45° FOV — 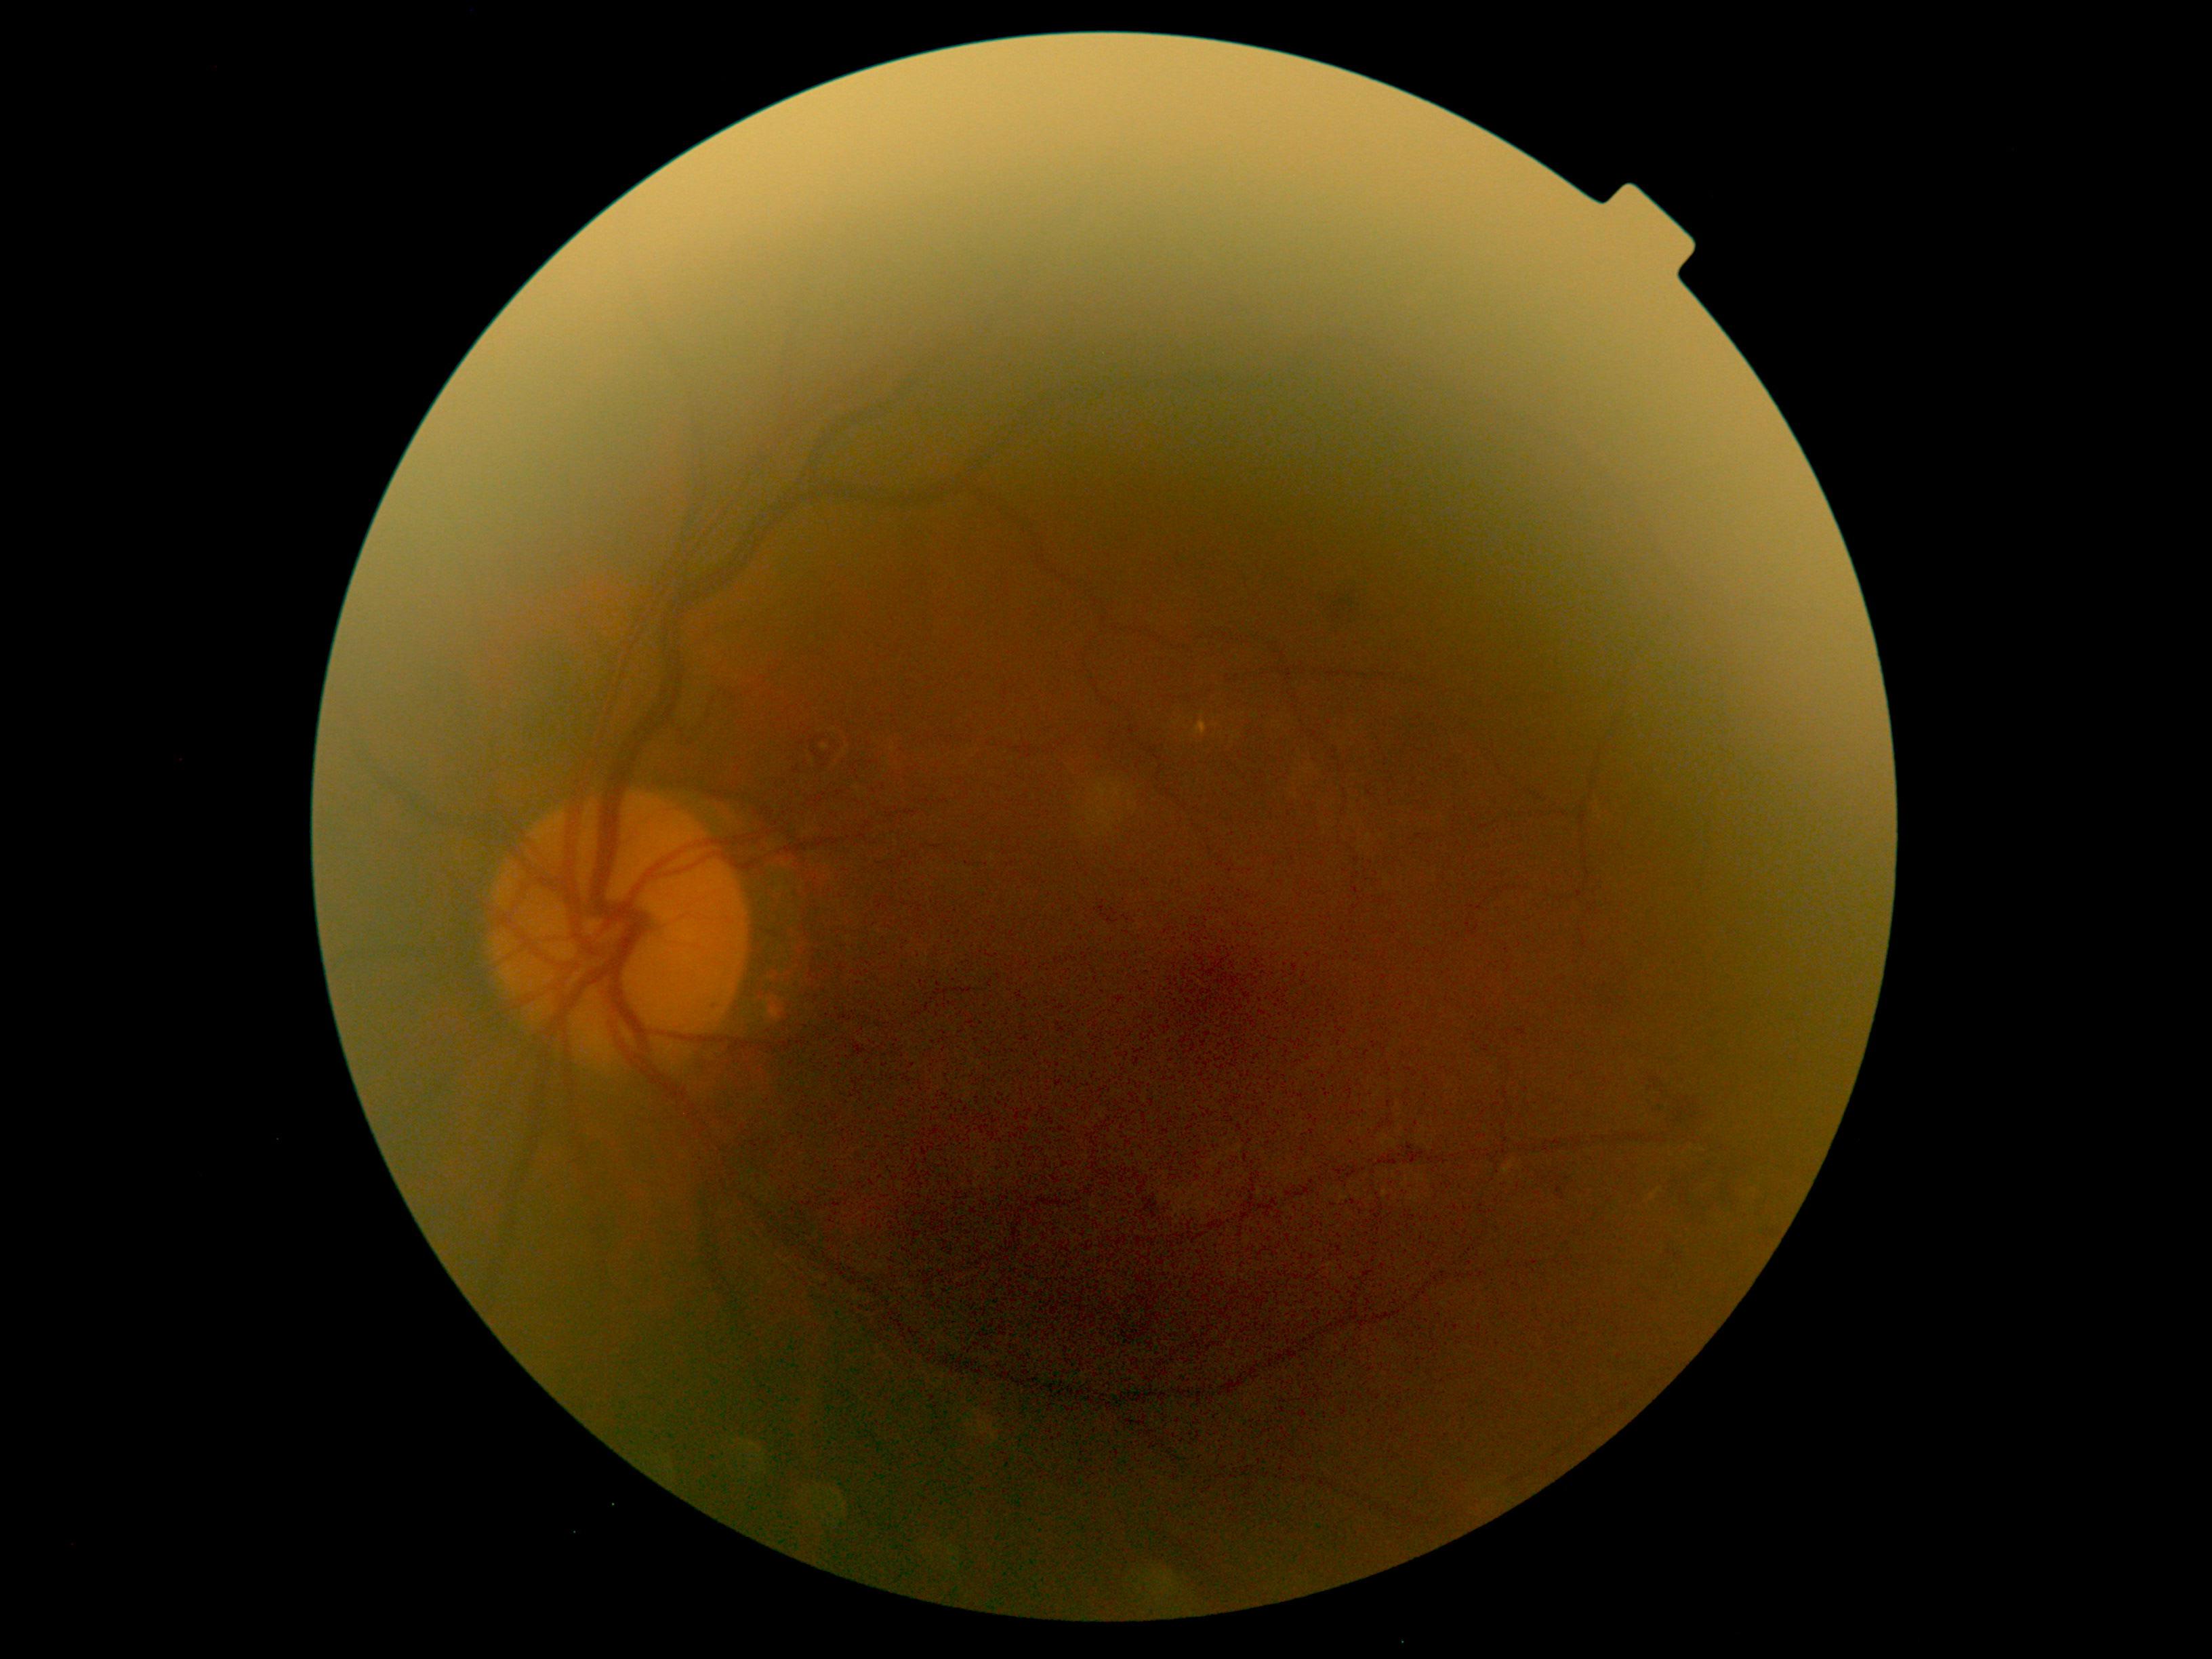
– diabetic retinopathy severity: grade 2 (moderate NPDR)